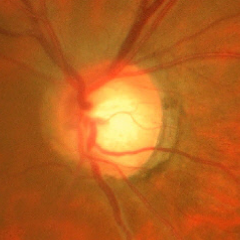 Glaucoma status: advanced glaucoma.